Acquired with a NIDEK AFC-230; fundus photo; modified Davis classification — 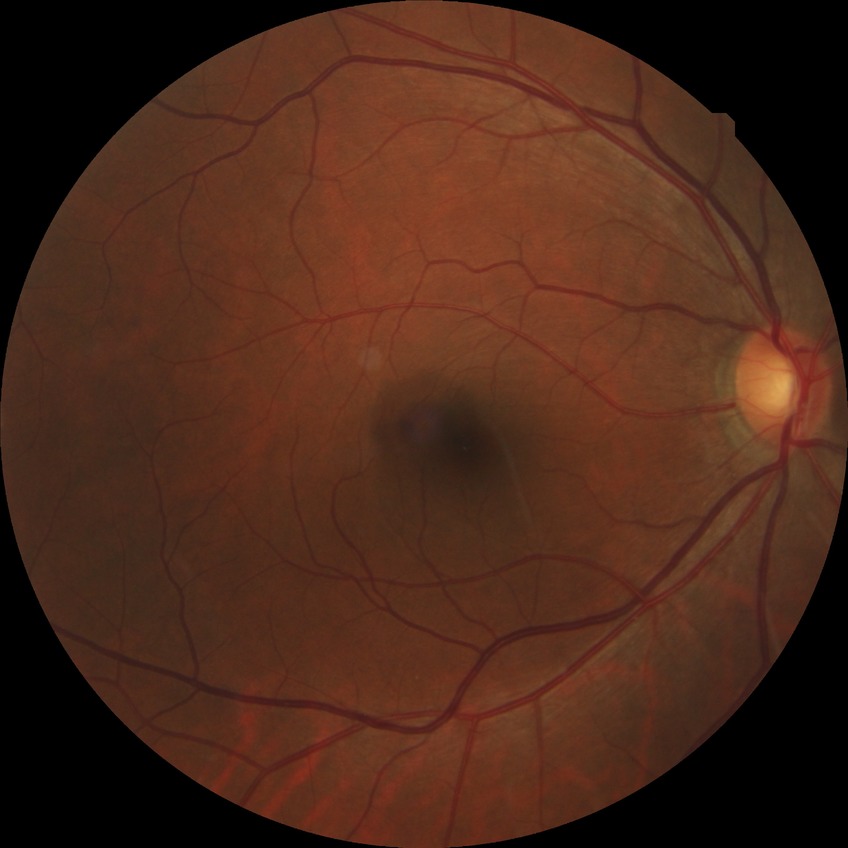

diabetic retinopathy (DR): NDR (no diabetic retinopathy).